Fundus photo. 848 by 848 pixels. Nonmydriatic fundus photograph
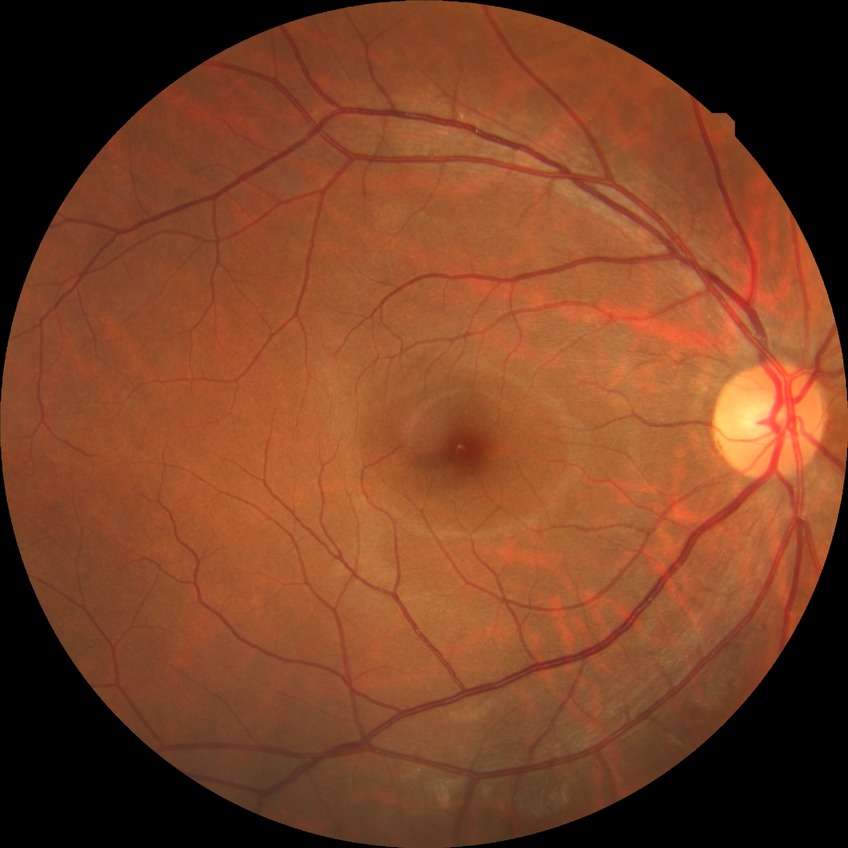

DR stage is NDR.